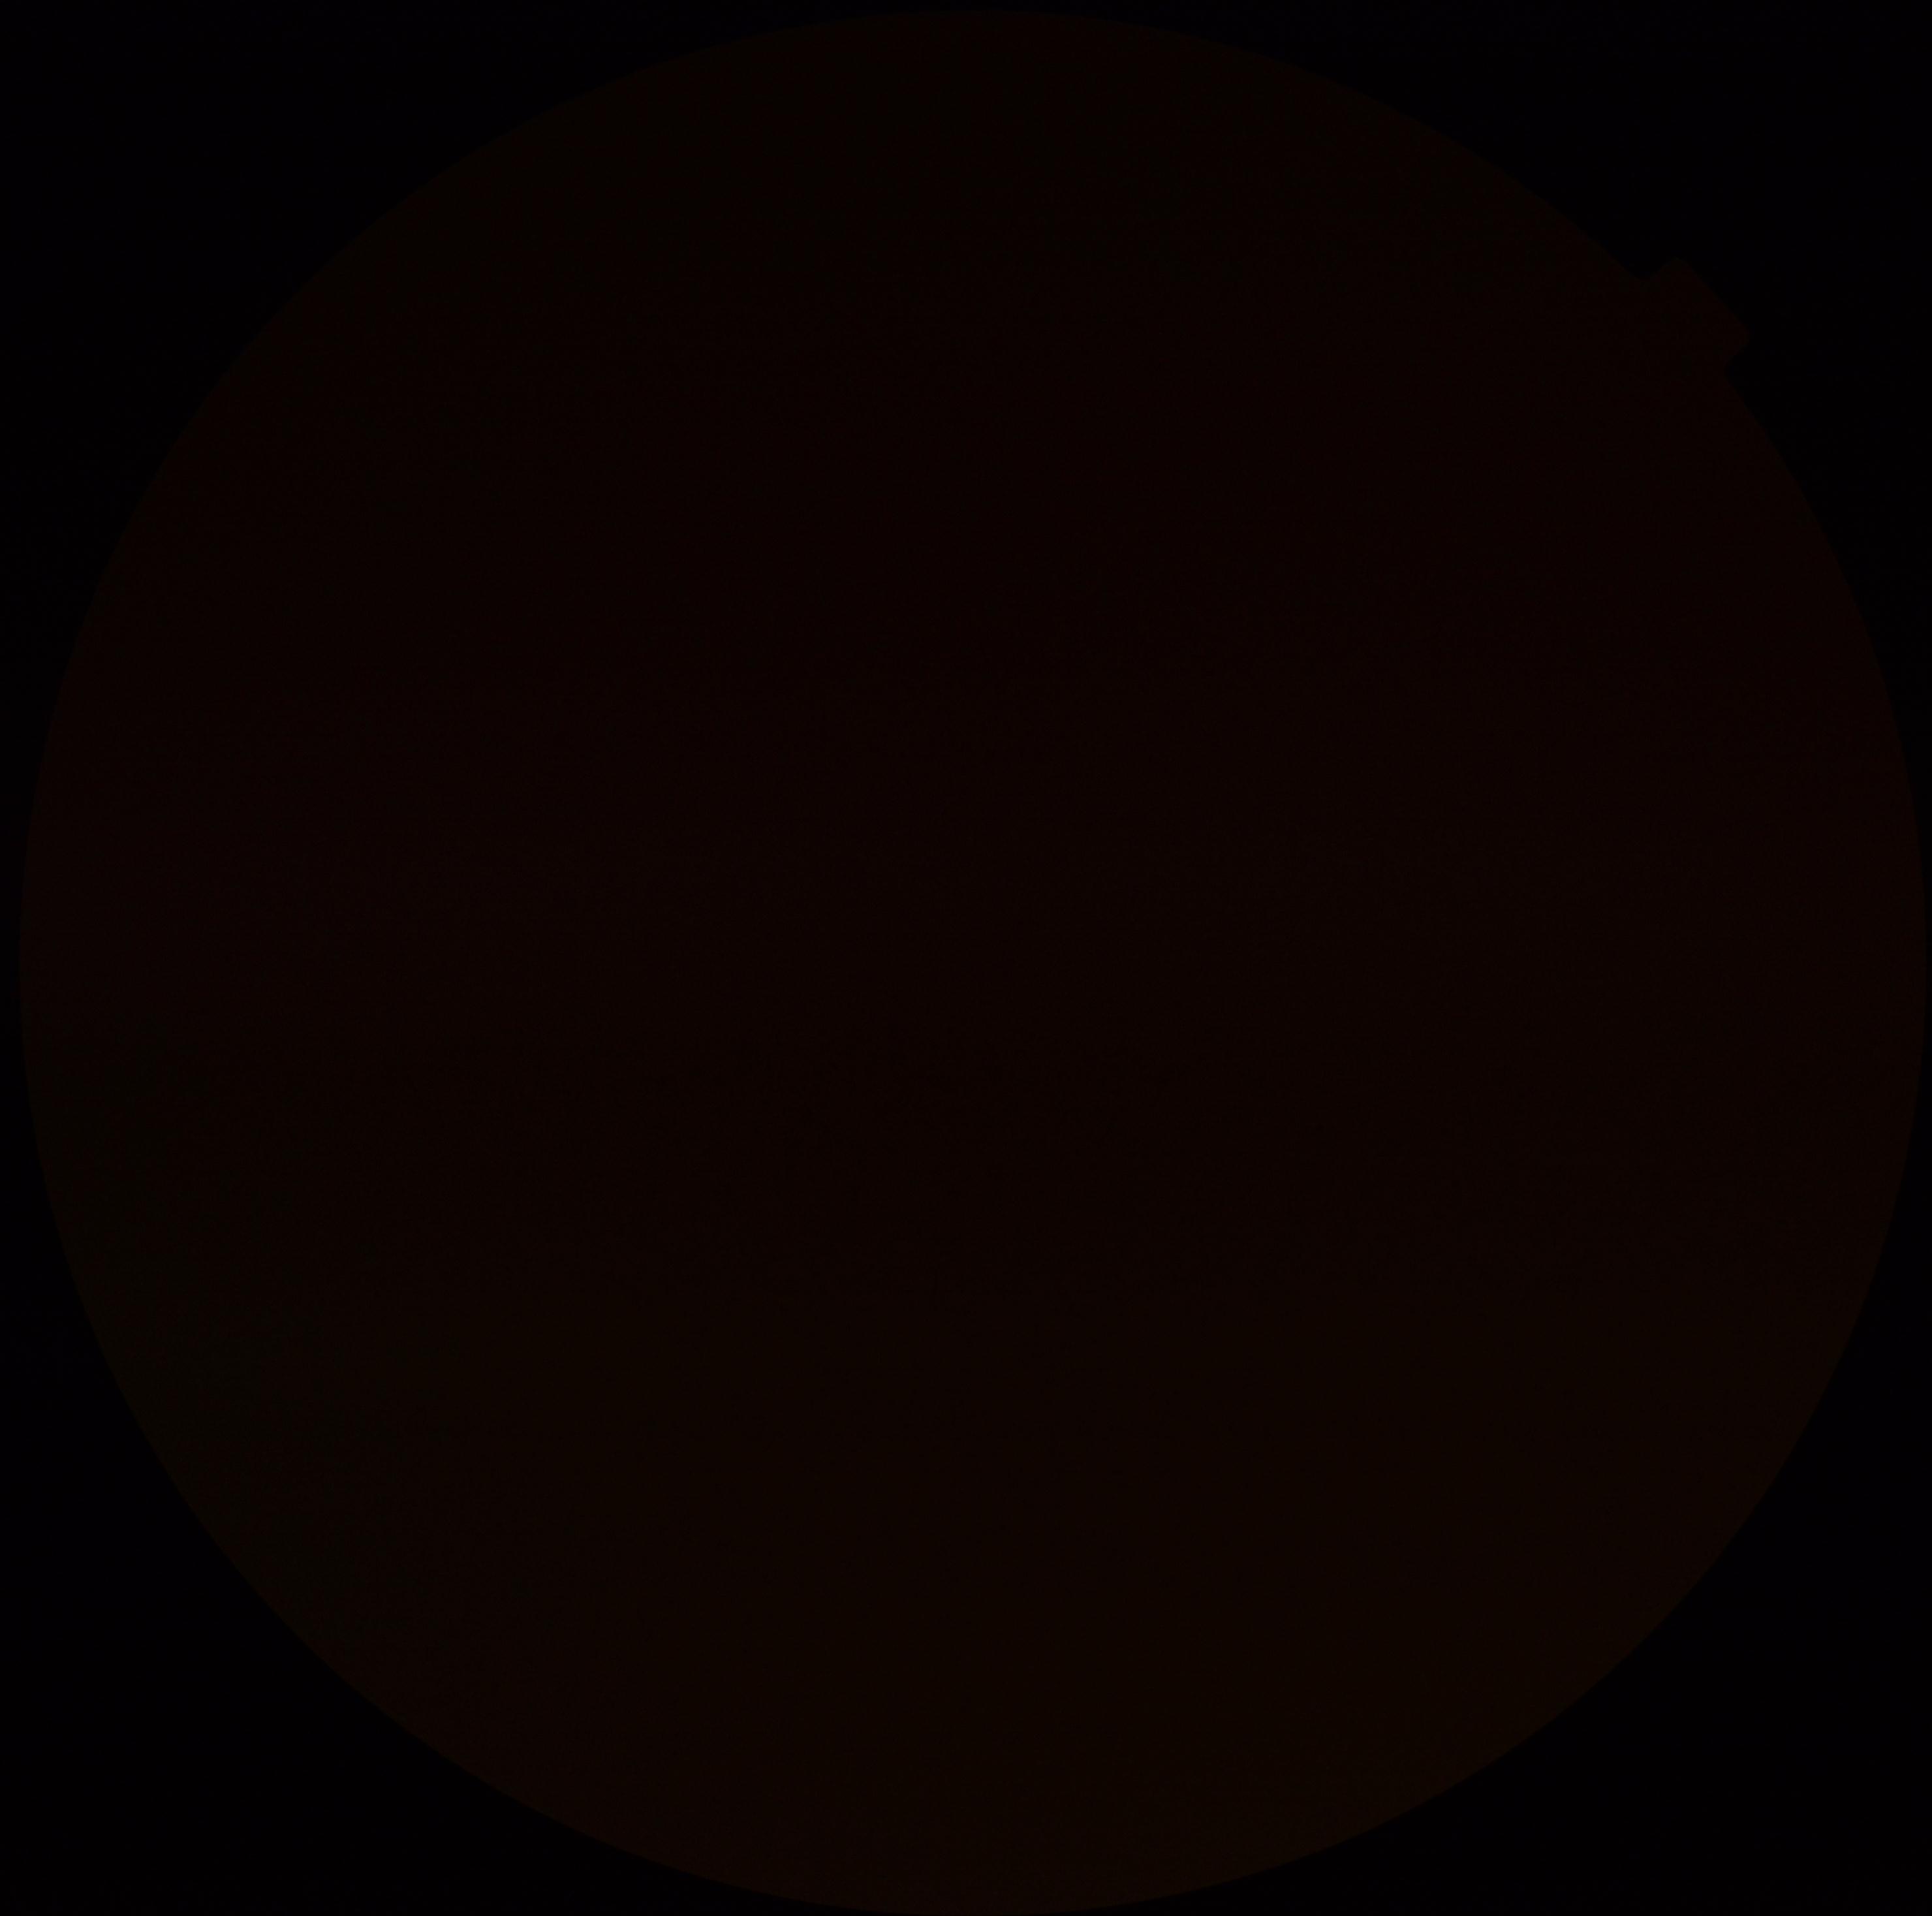

Diabetic retinopathy severity: ungradable due to poor image quality.